45° FOV, CFP, 2048 by 1536 pixels
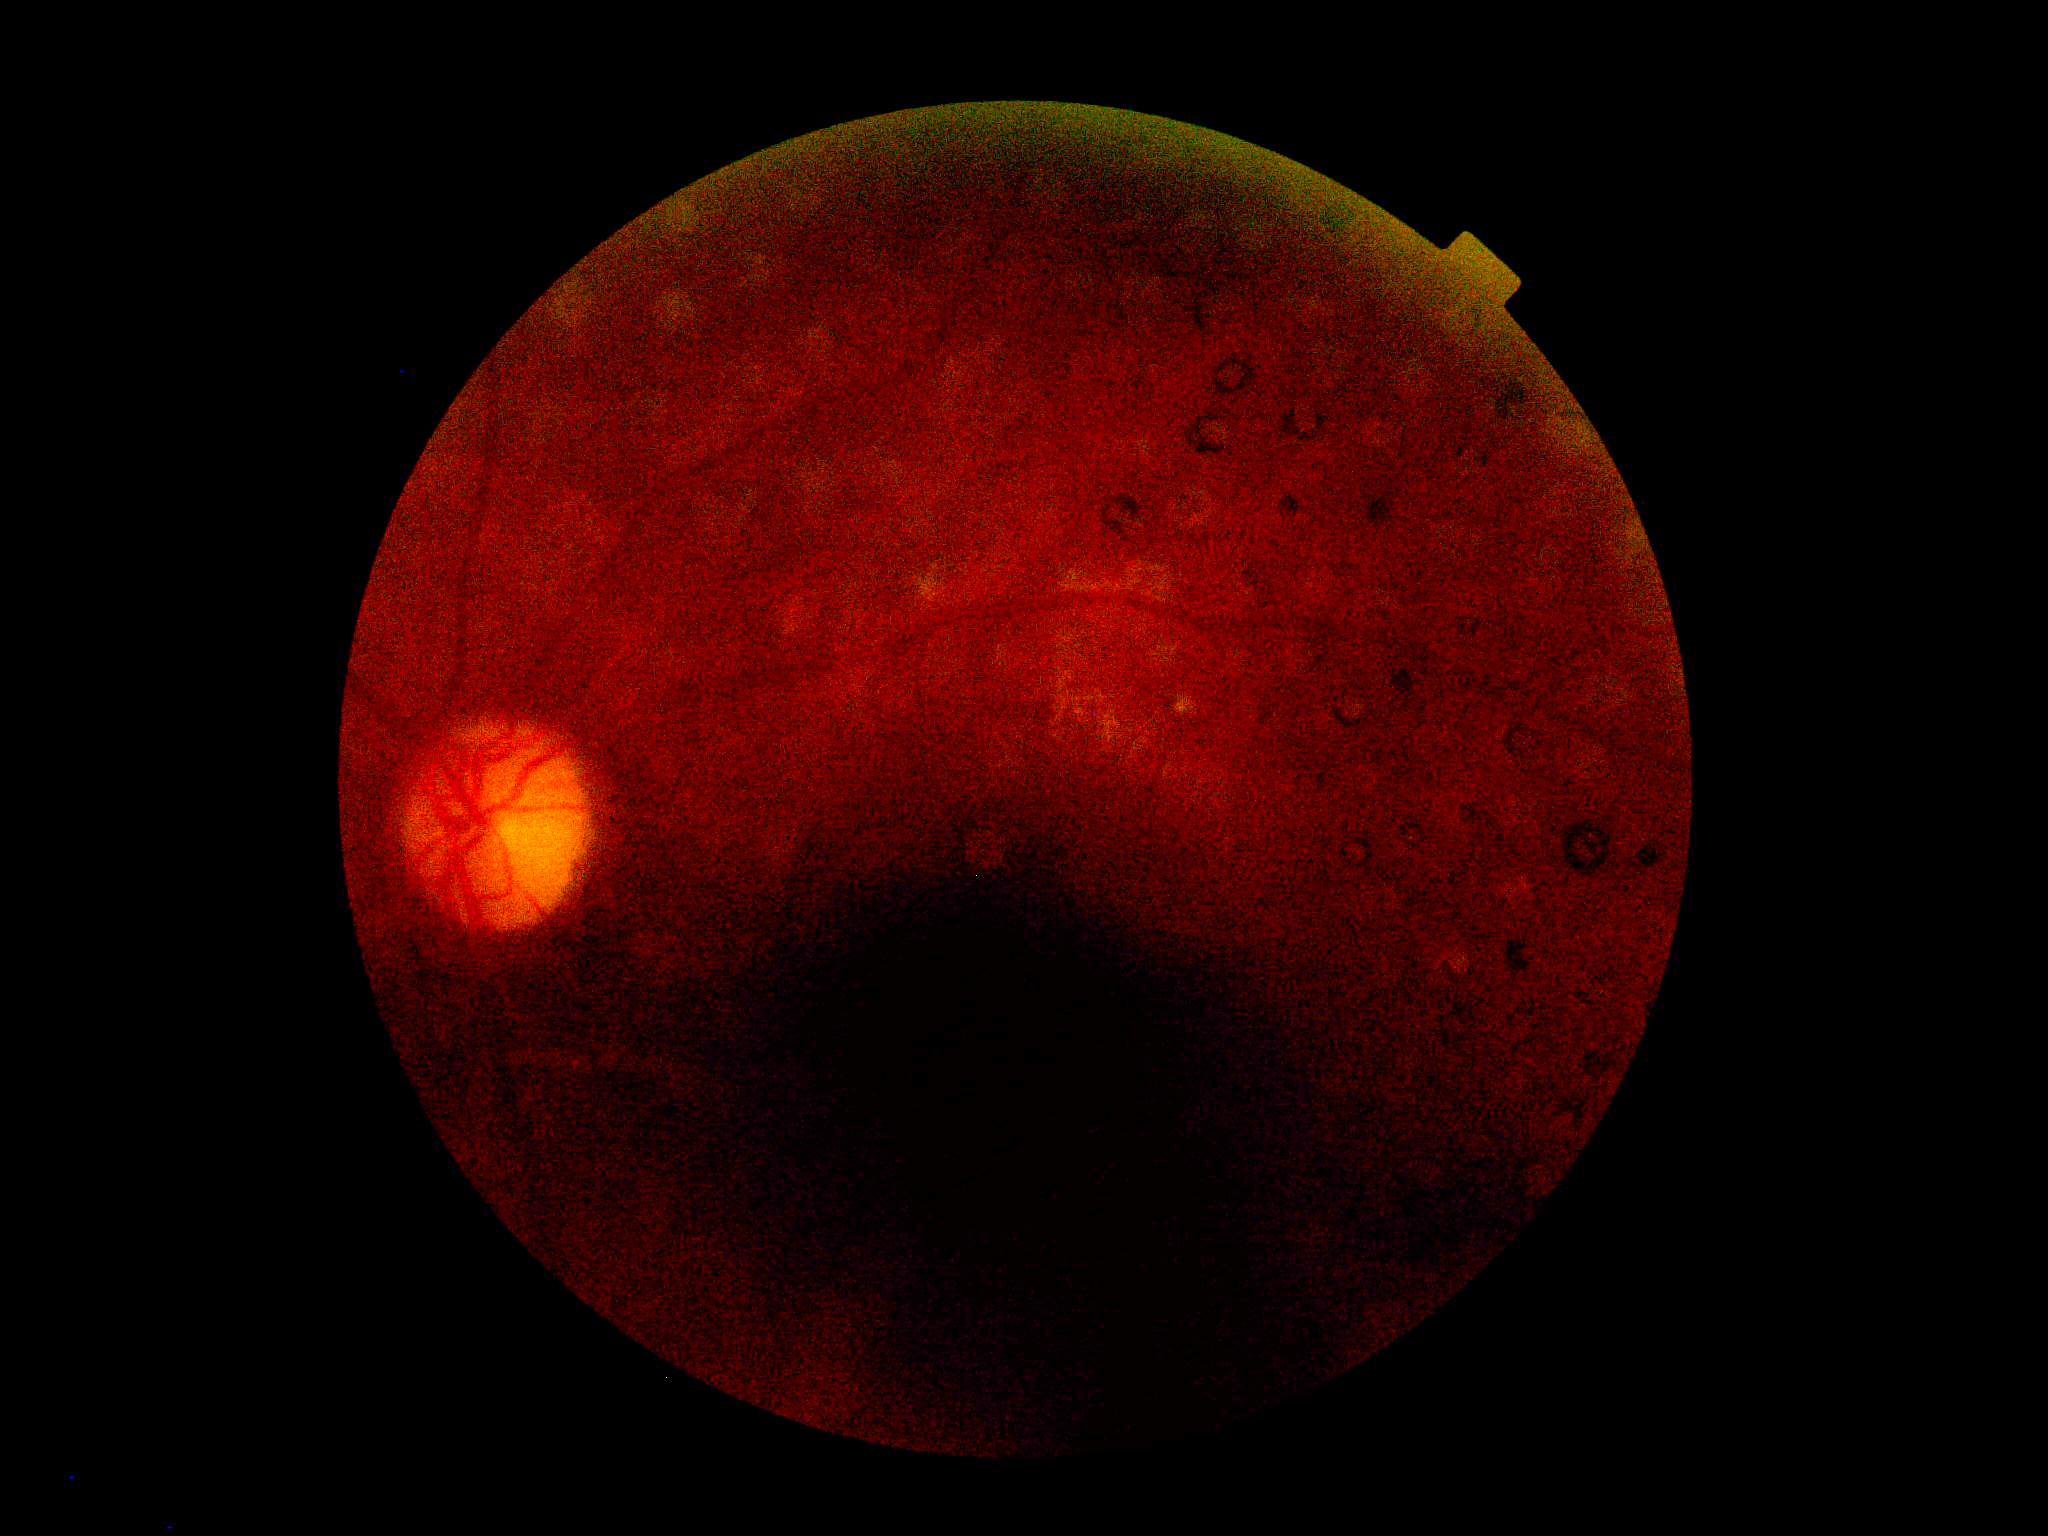 Diabetic retinopathy is ungradable.